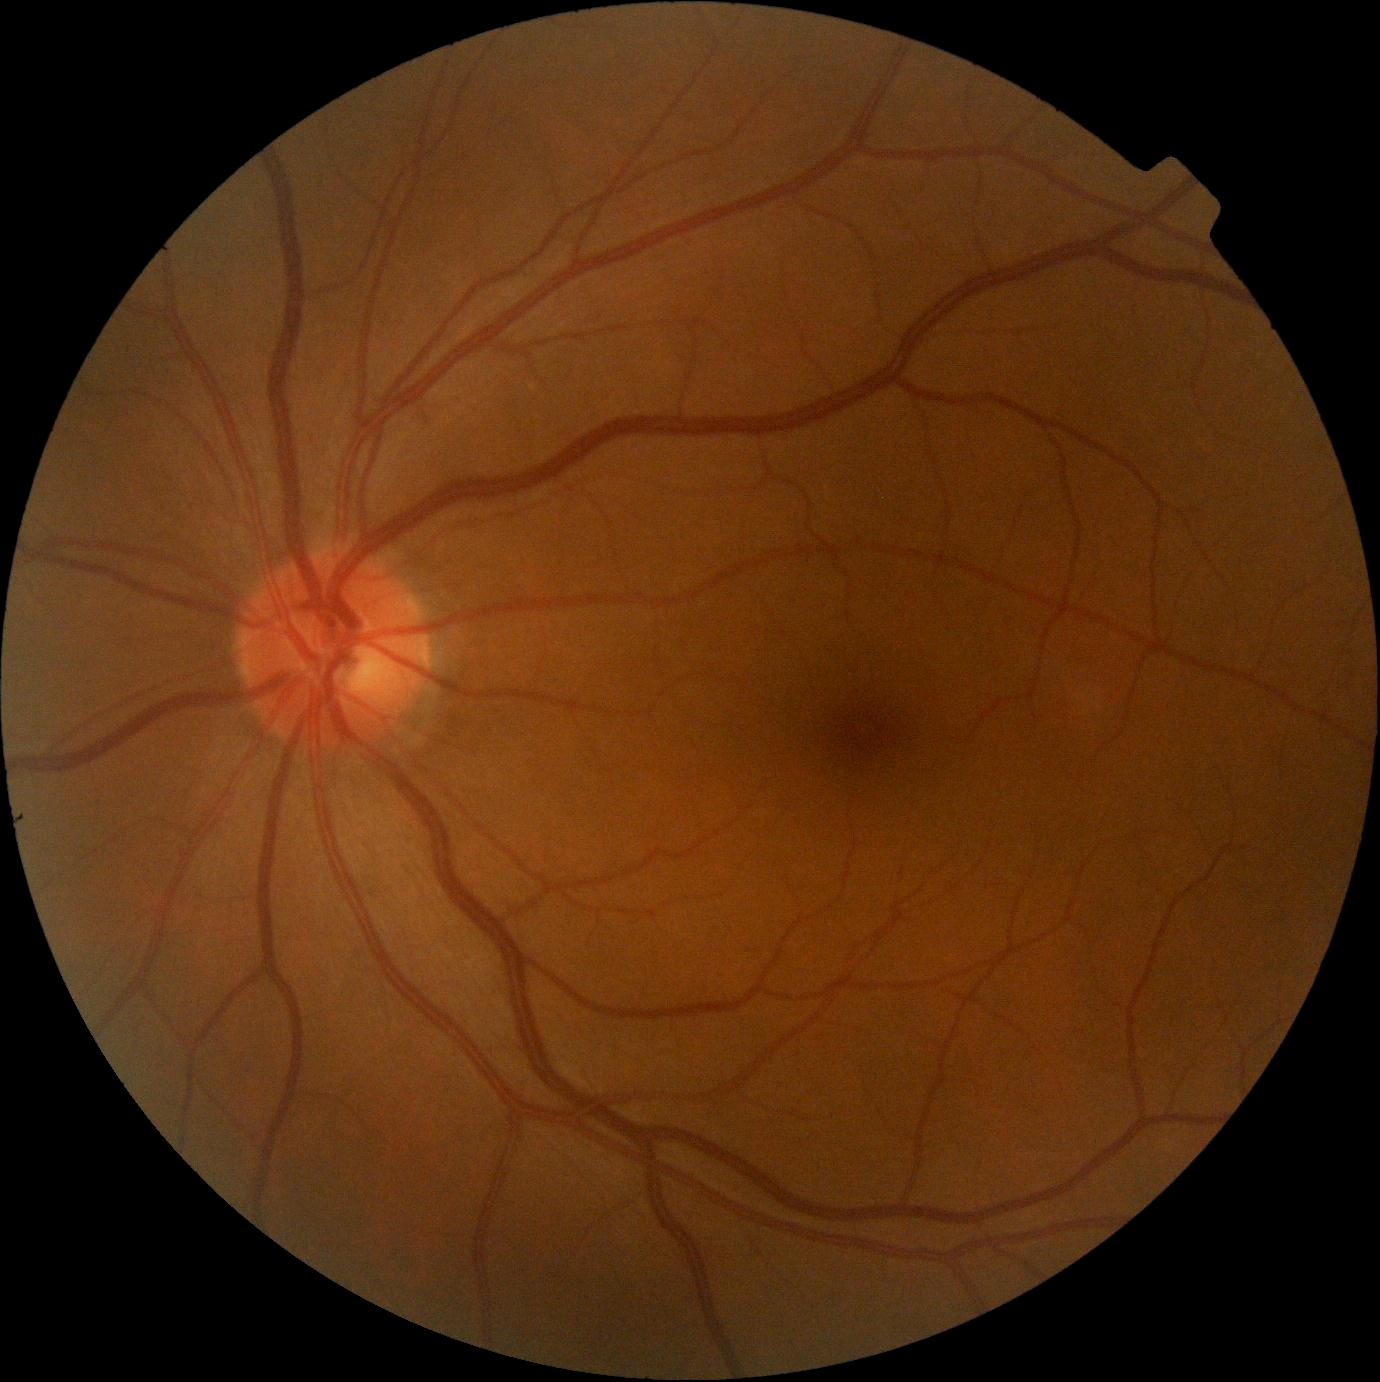 Diabetic retinopathy (DR) is no apparent retinopathy (grade 0).